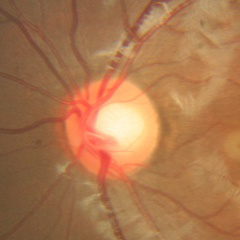 Glaucoma diagnosis: no glaucomatous optic neuropathy.